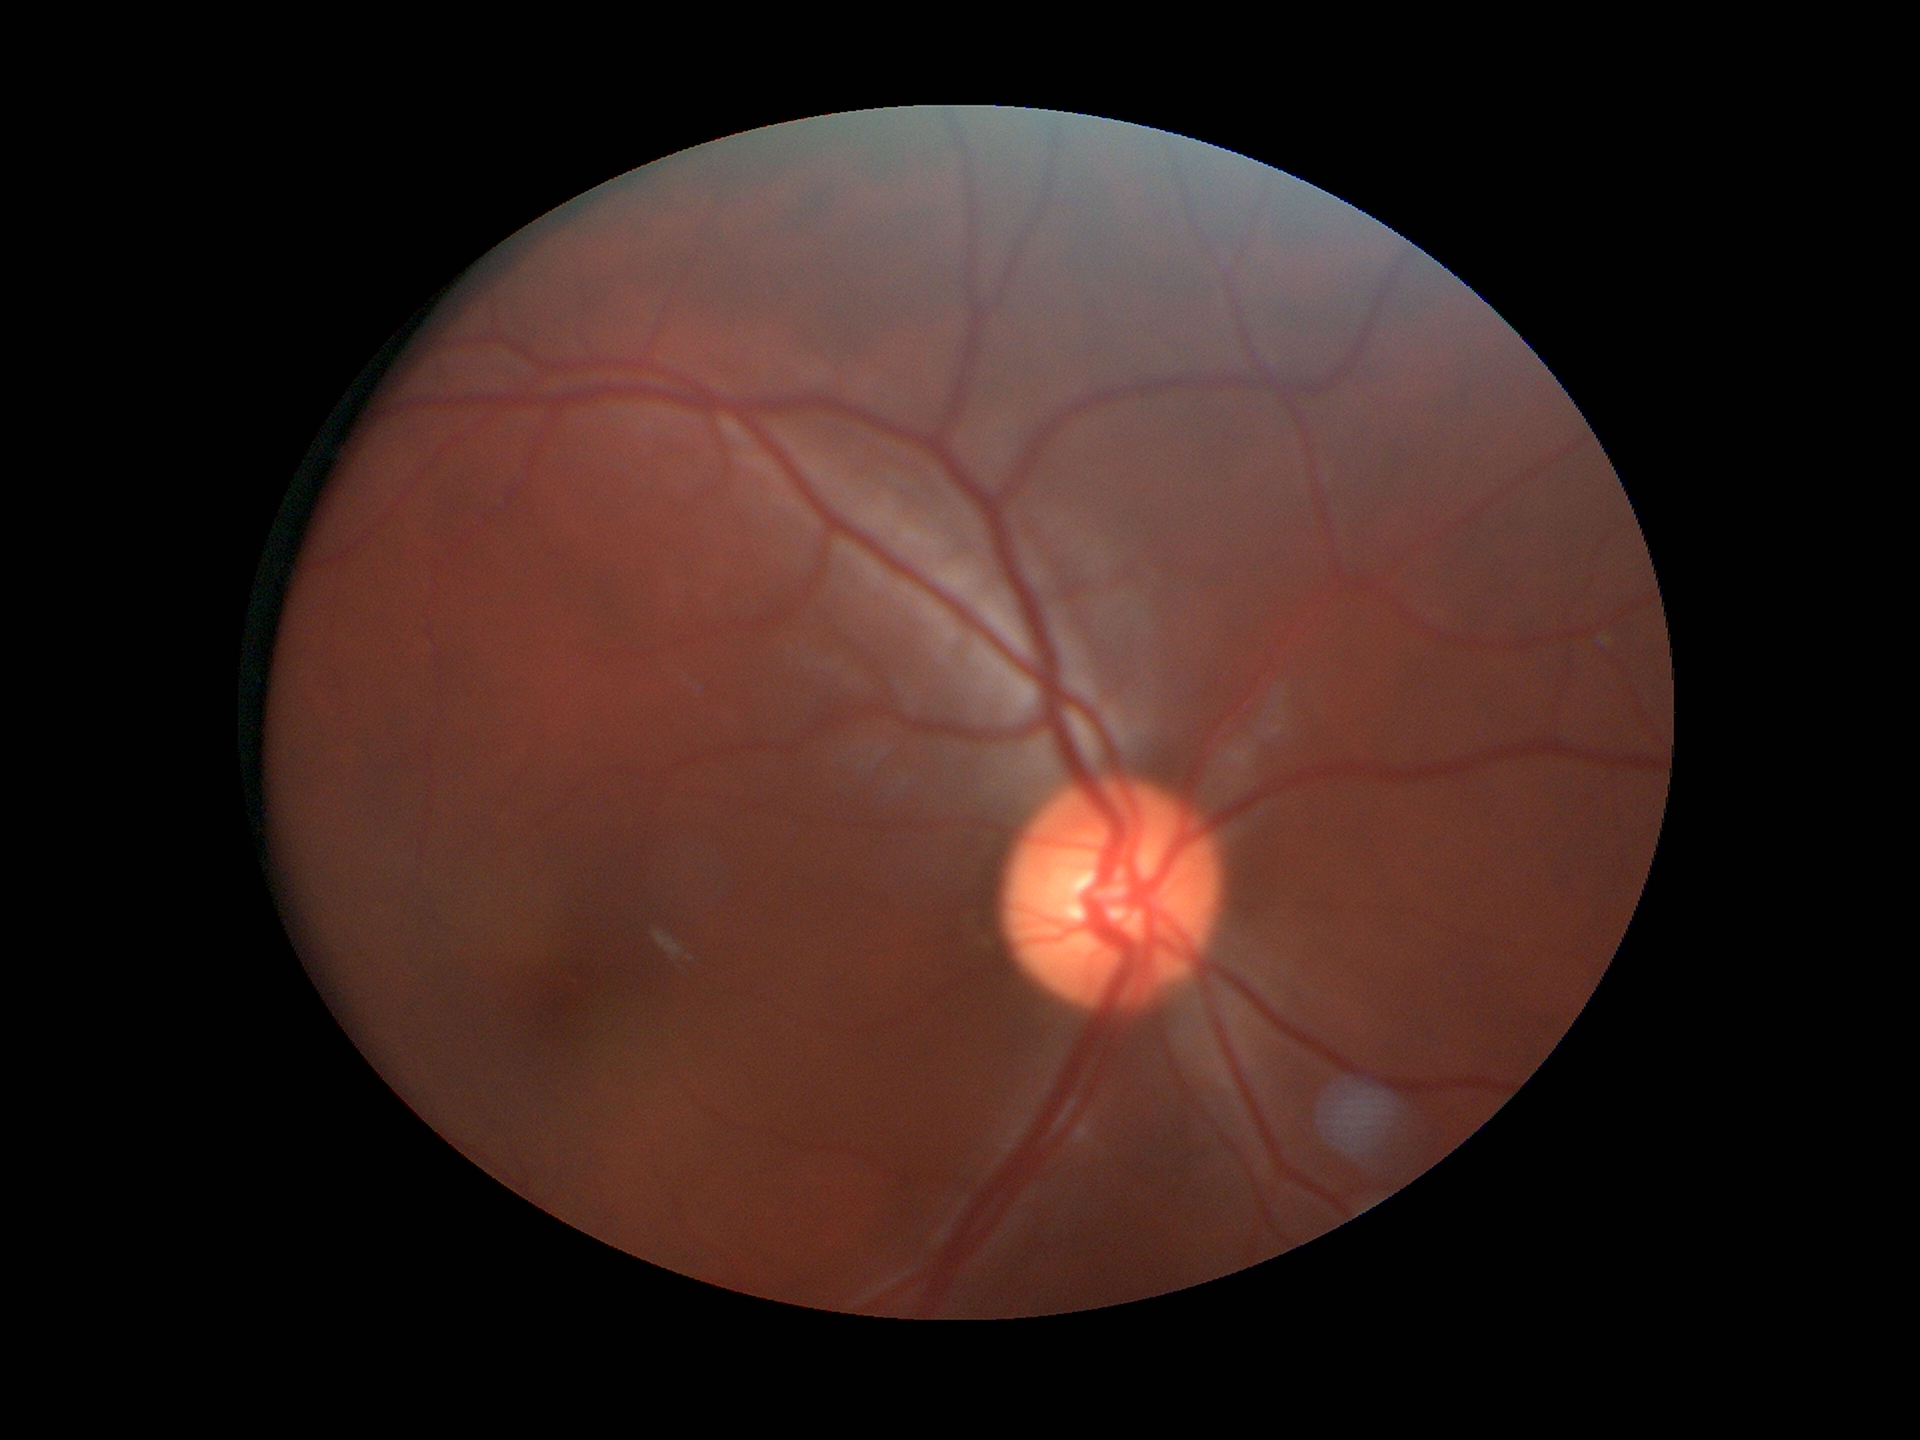
Horizontal cup-to-disc ratio of 0.50.
No signs of glaucoma (5/5 ophthalmologists in agreement).
Vertical CDR: 0.49.